Image size 2212x1659 · color fundus photograph · 45° FOV.
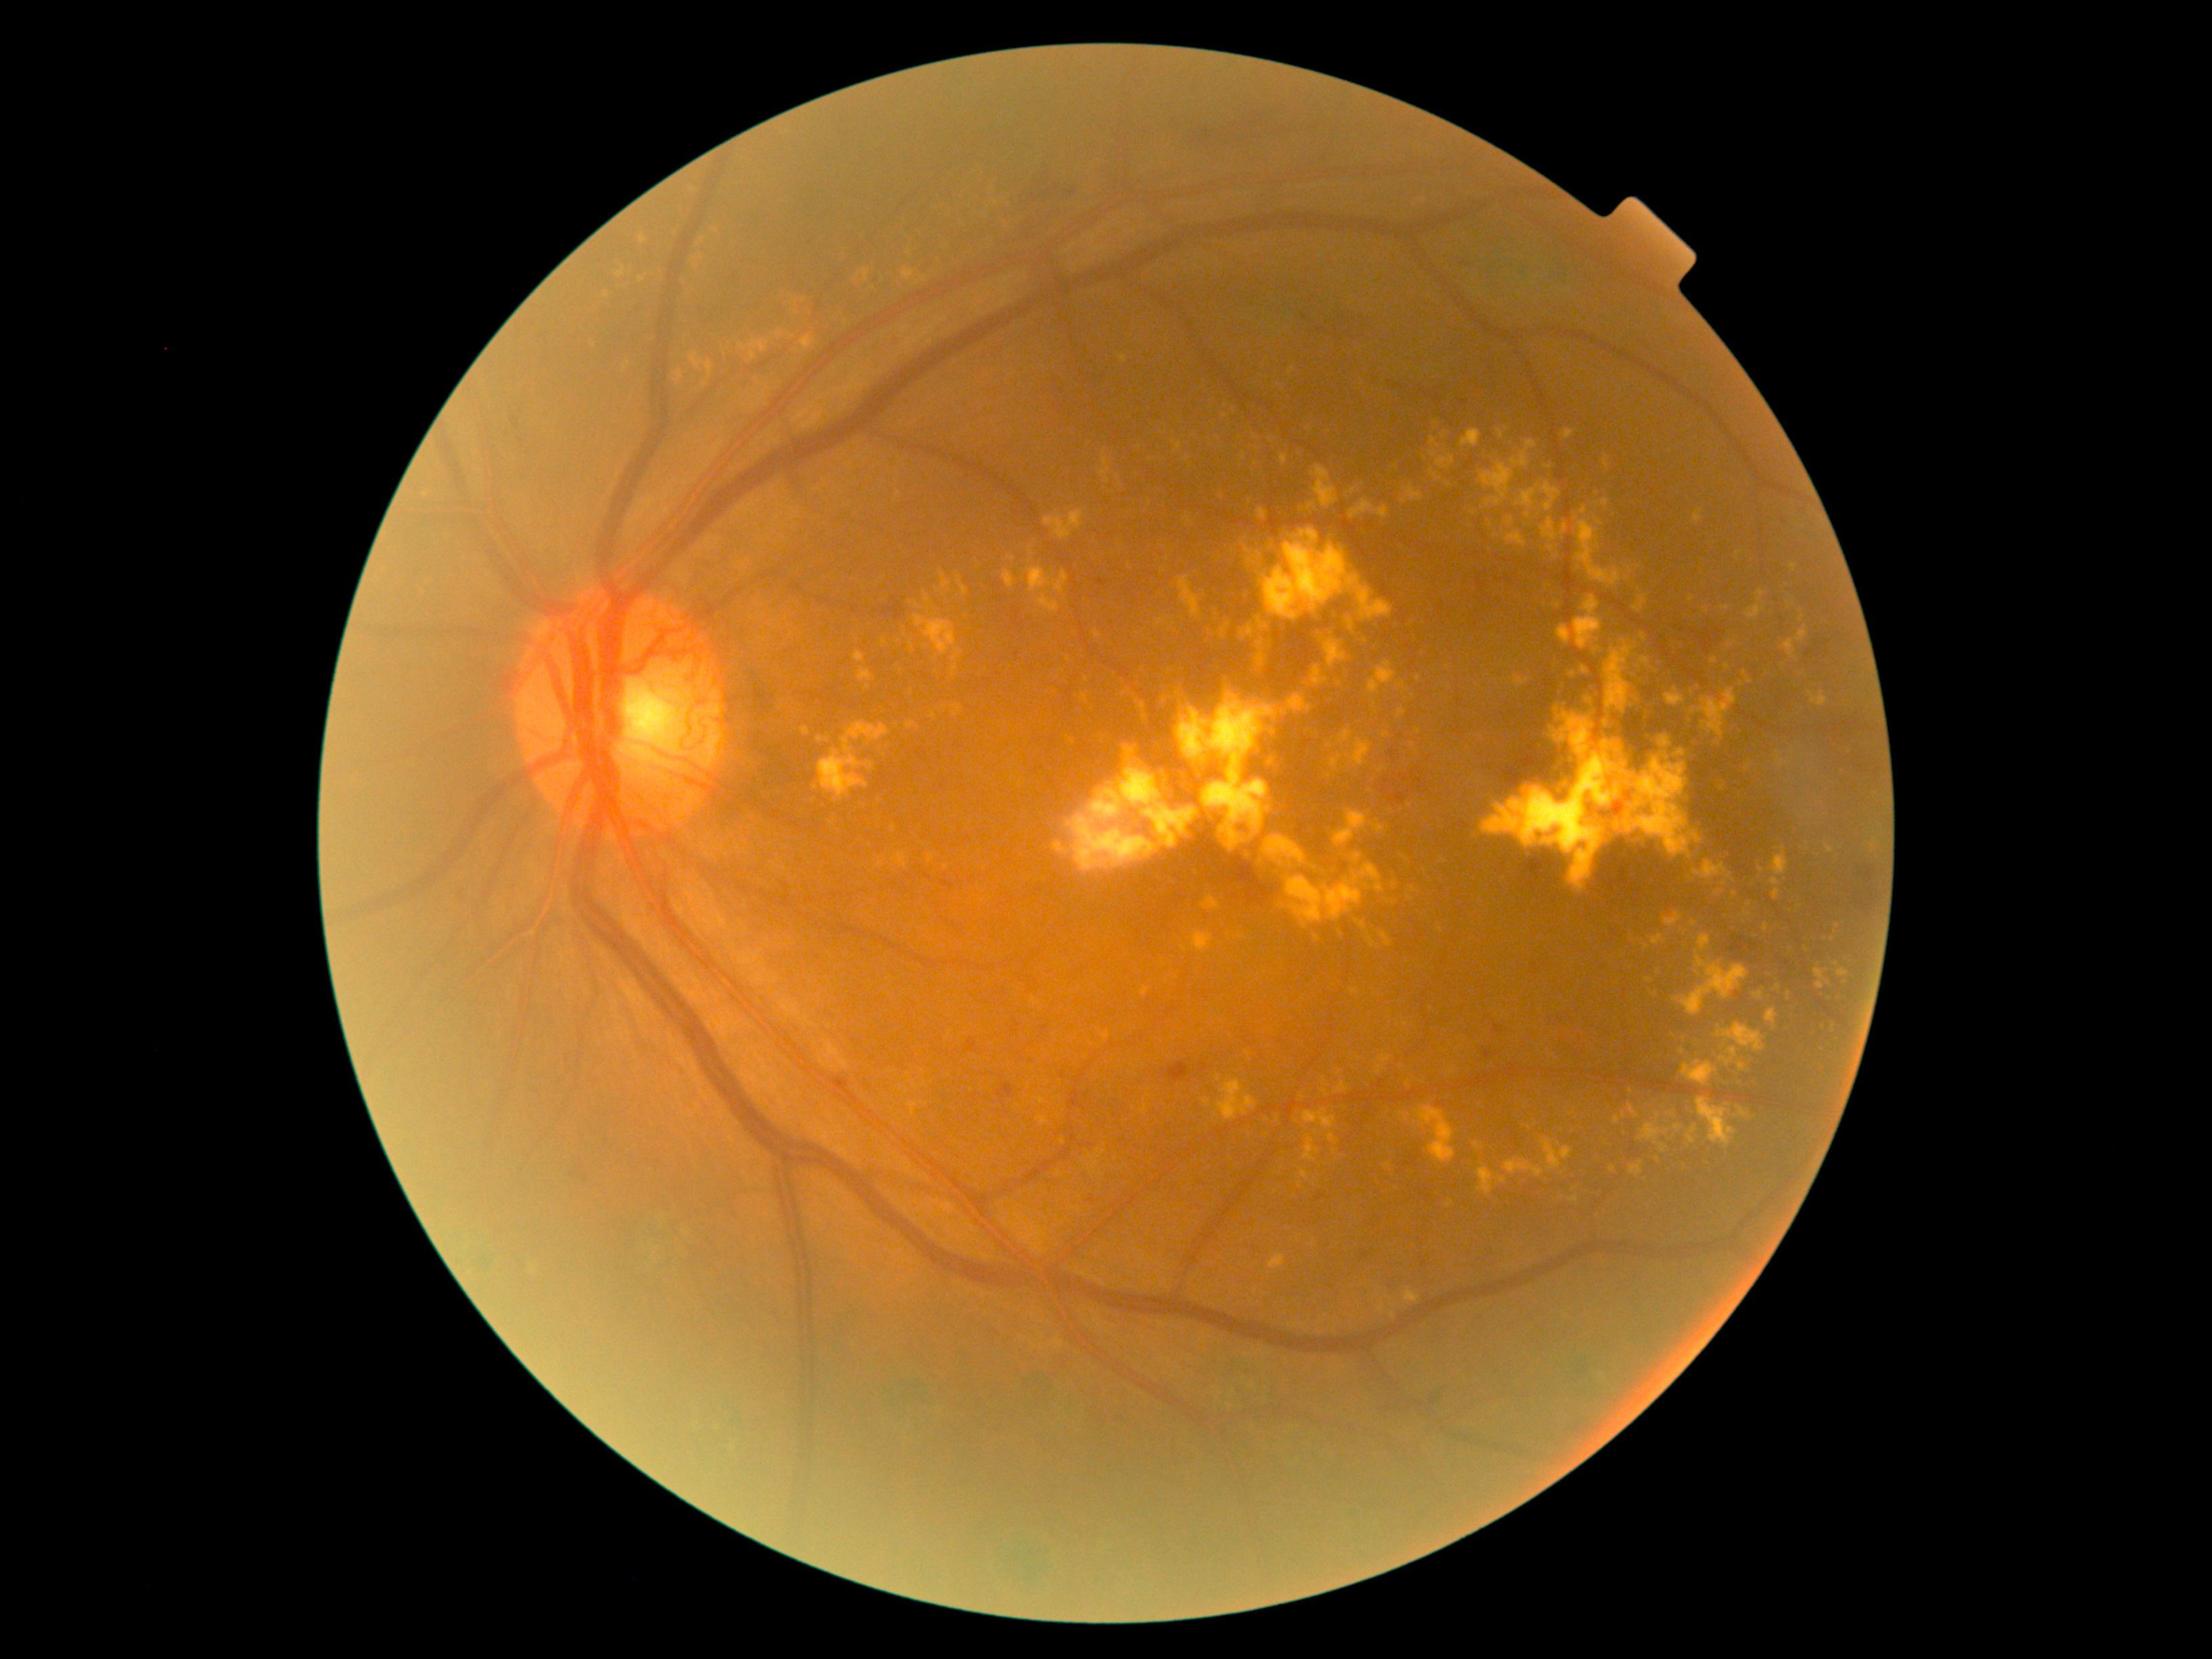
DR stage: grade 4
A subset of detected lesions:
EXs (more not shown): left=1398, top=682, right=1406, bottom=689, left=1286, top=864, right=1385, bottom=928, left=1615, top=1116, right=1620, bottom=1124, left=1593, top=734, right=1600, bottom=752, left=1240, top=627, right=1254, bottom=642, left=1505, top=518, right=1515, bottom=527, left=1044, top=510, right=1084, bottom=540, left=897, top=853, right=907, bottom=868, left=1081, top=693, right=1088, bottom=703, left=1477, top=1168, right=1496, bottom=1195, left=1557, top=626, right=1572, bottom=646, left=1299, top=1170, right=1309, bottom=1180
Additional small EXs near {"x": 1248, "y": 1054}, {"x": 1030, "y": 556}, {"x": 1367, "y": 641}, {"x": 1404, "y": 1116}, {"x": 866, "y": 281}, {"x": 1414, "y": 890}, {"x": 1140, "y": 446}, {"x": 1386, "y": 735}